Diabetic retinopathy graded by the modified Davis classification, 45° FOV, 848 x 848 pixels
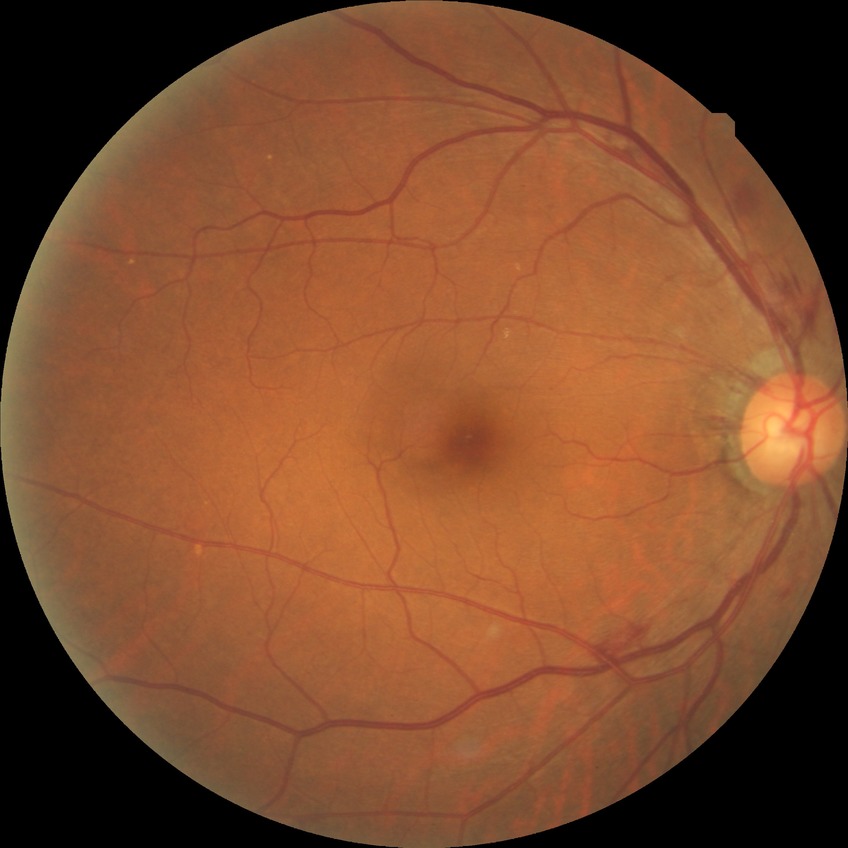
diabetic retinopathy (DR)@SDR (simple diabetic retinopathy).